Modified Davis classification. Posterior pole color fundus photograph. NIDEK AFC-230
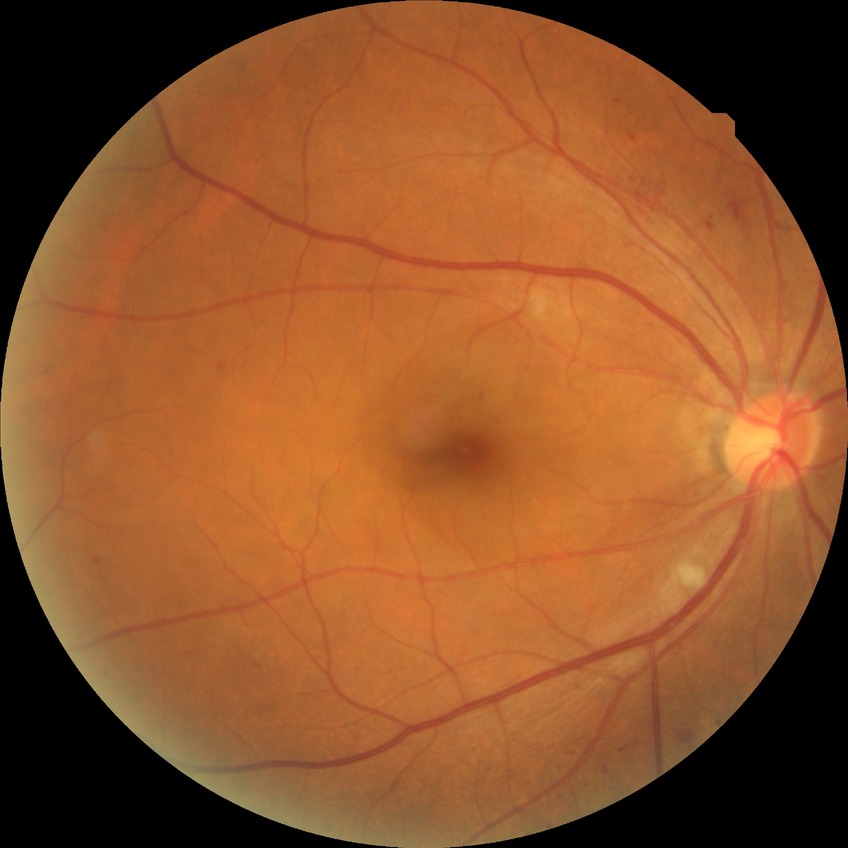

DR: SDR.